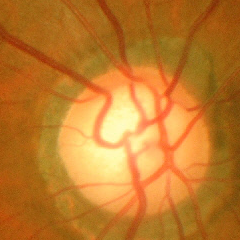 Advanced glaucoma.